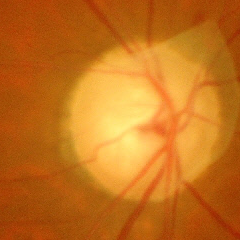

Findings consistent with glaucoma. Glaucoma stage: advanced glaucoma.